Color fundus photograph; 45° FOV: 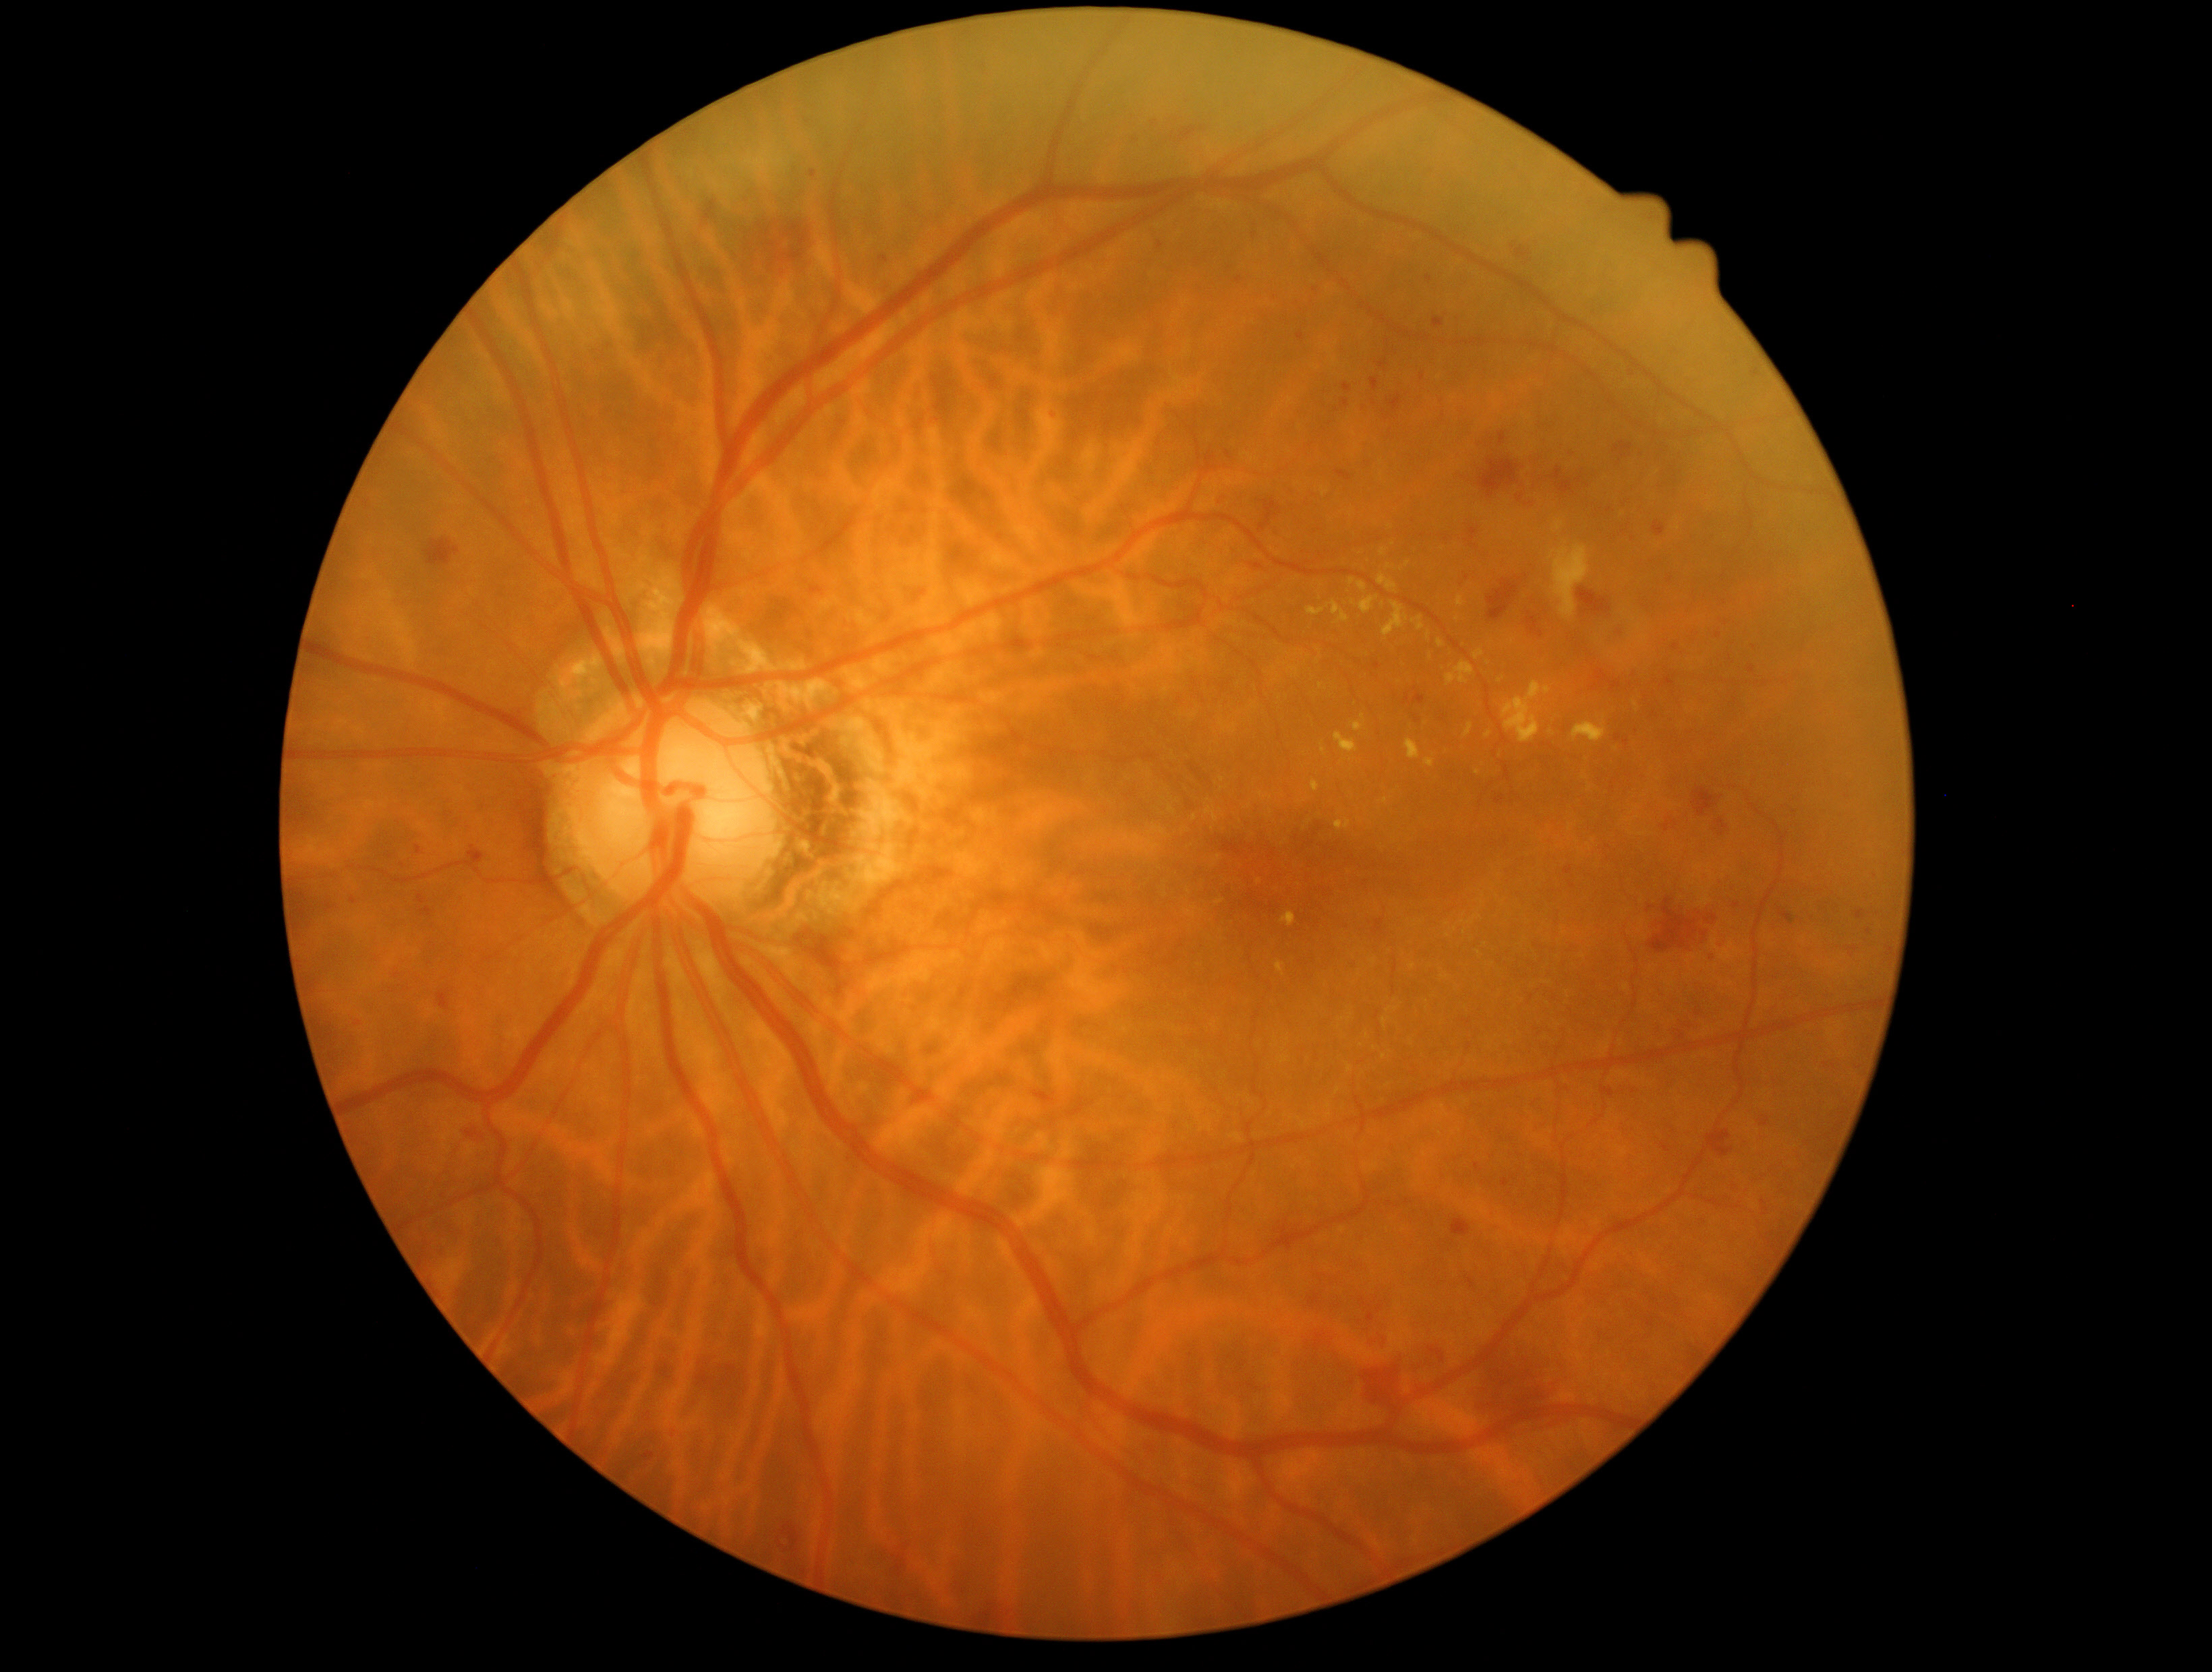
{"partial": true, "dr_grade": 2, "lesions": {"he": [[1487, 580, 1521, 621], [1158, 241, 1165, 249], [1452, 315, 1467, 327], [1259, 500, 1282, 532], [1235, 277, 1243, 285], [1495, 796, 1506, 806], [782, 1523, 799, 1554], [1205, 451, 1220, 474], [436, 989, 454, 1012], [1308, 1292, 1321, 1309], [1564, 866, 1573, 876], [1358, 402, 1372, 413], [895, 1555, 907, 1577]], "he_small": [[908, 1546], [1688, 1026], [1386, 416], [402, 866], [1763, 1204]]}}